Color fundus photograph · 2212 x 1659 pixels
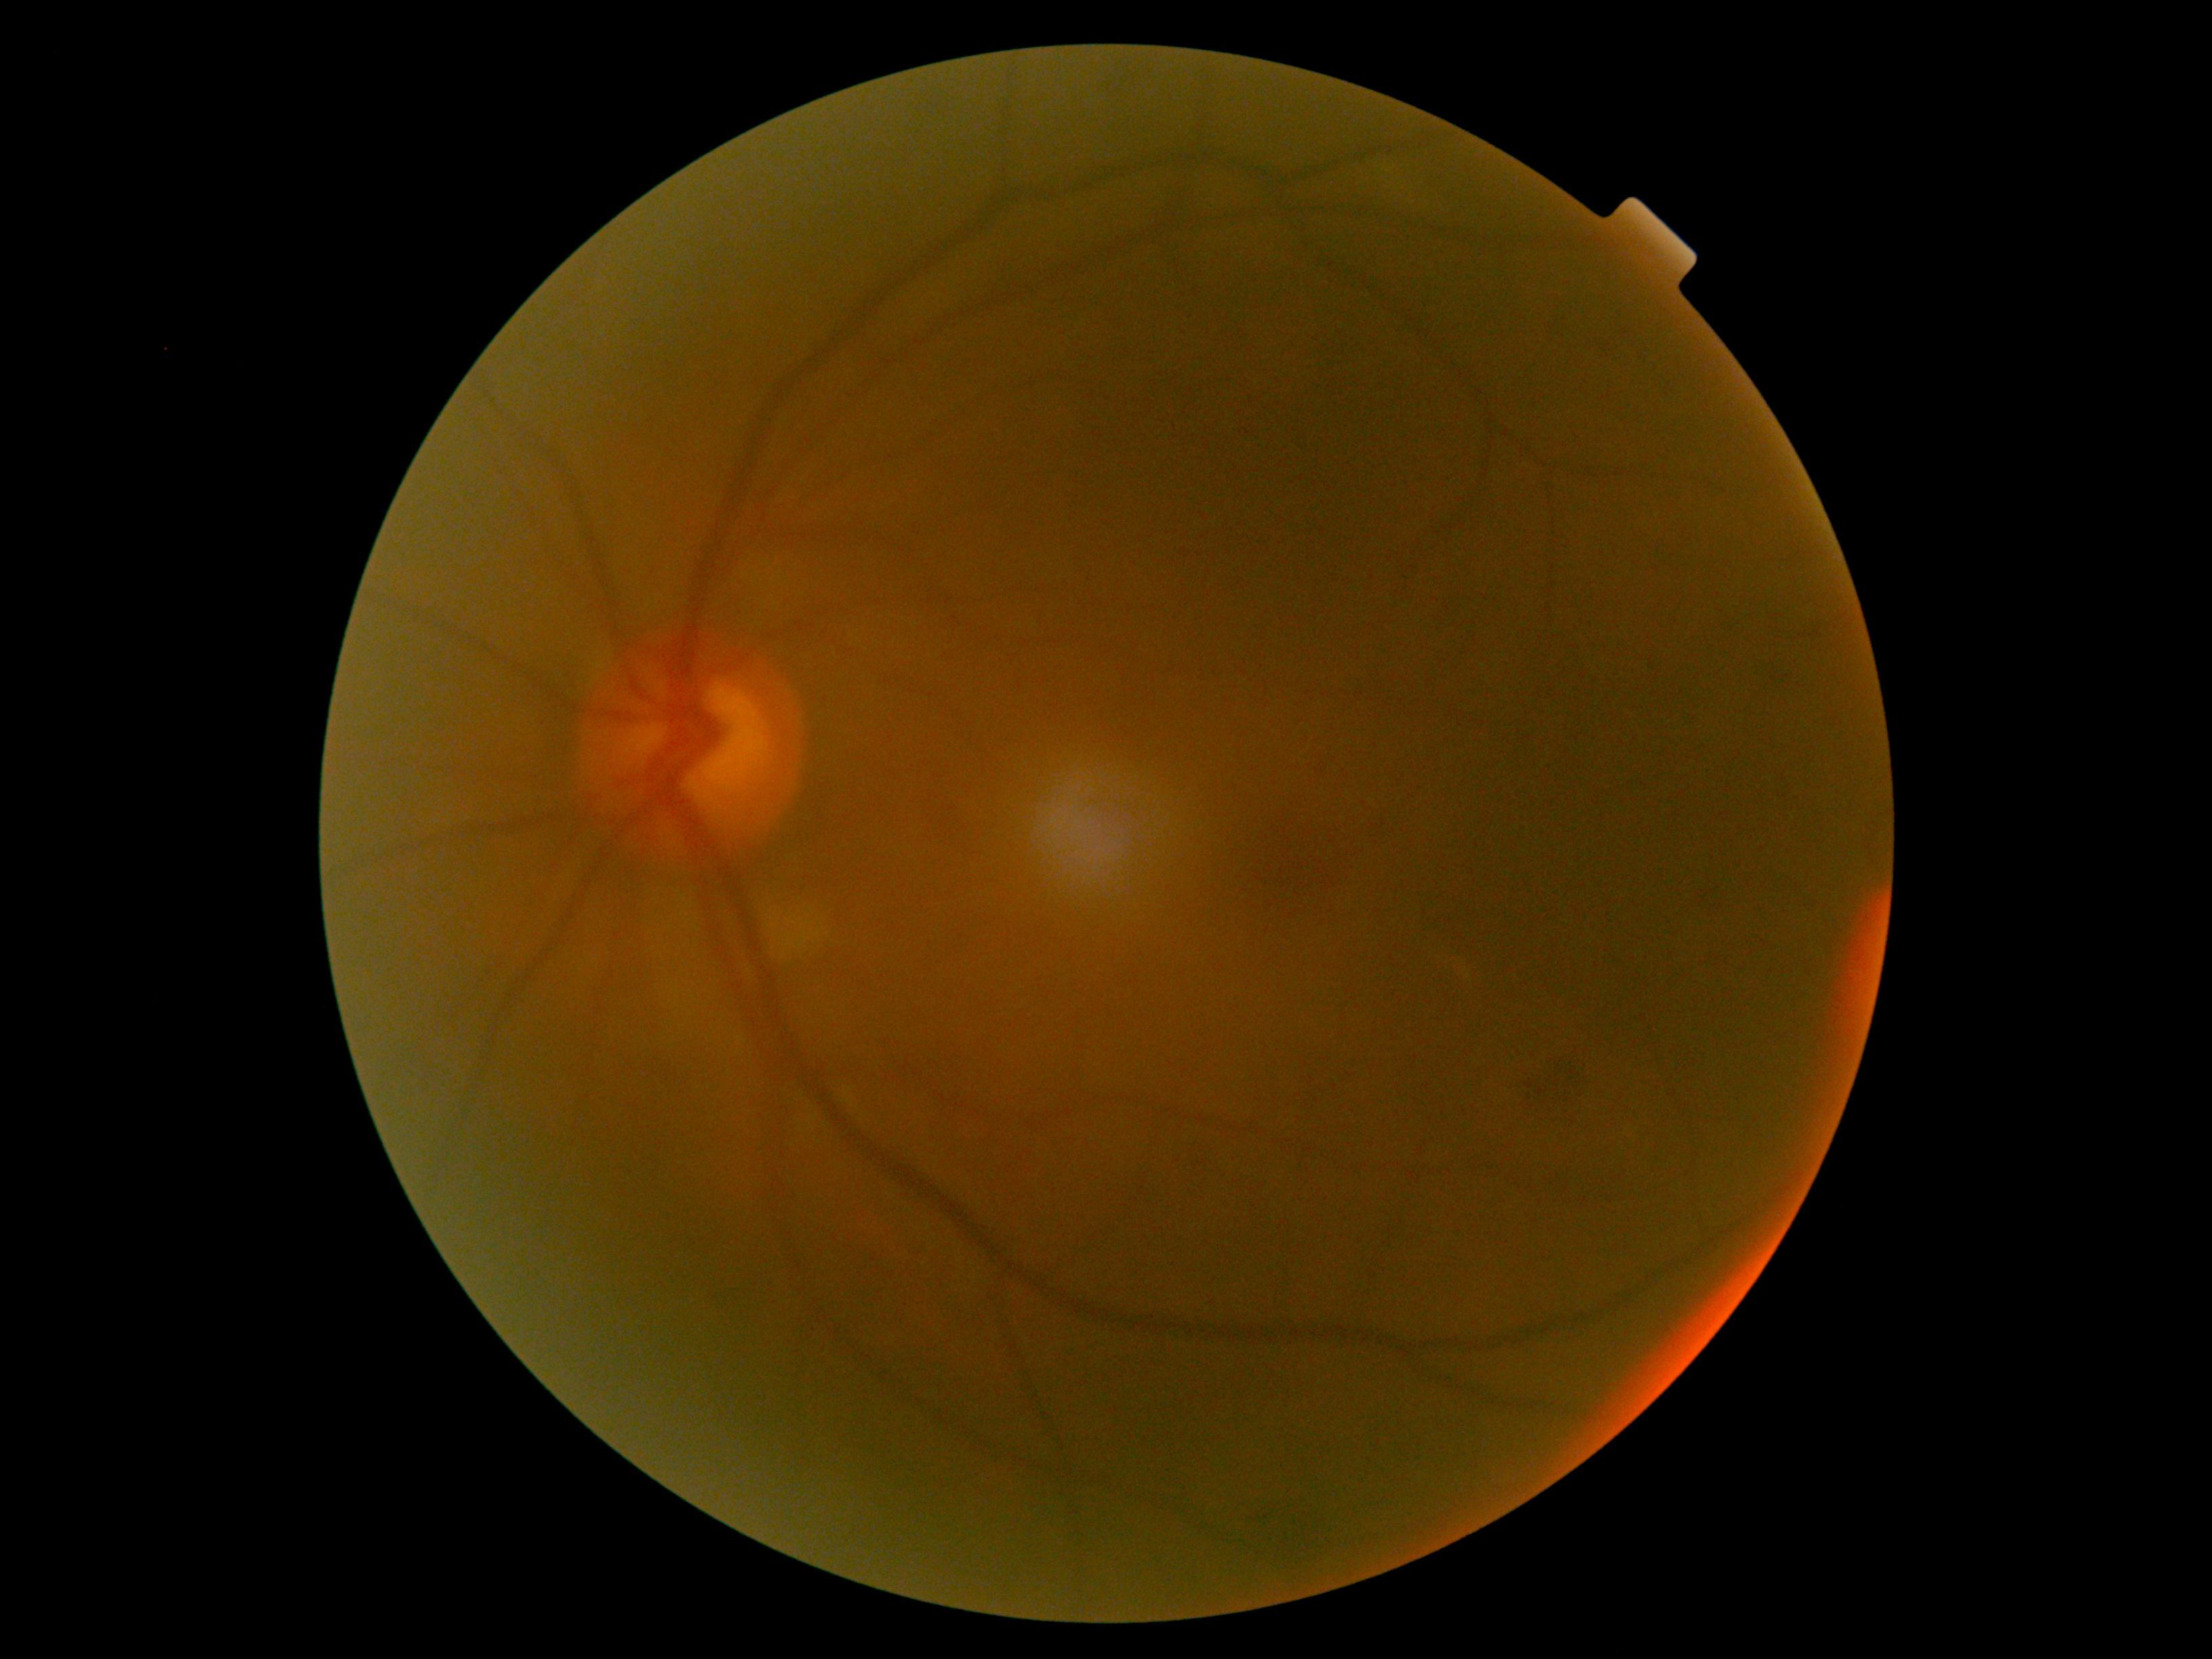

• DR class: non-proliferative diabetic retinopathy
• DR severity: 2